Fundus photo:
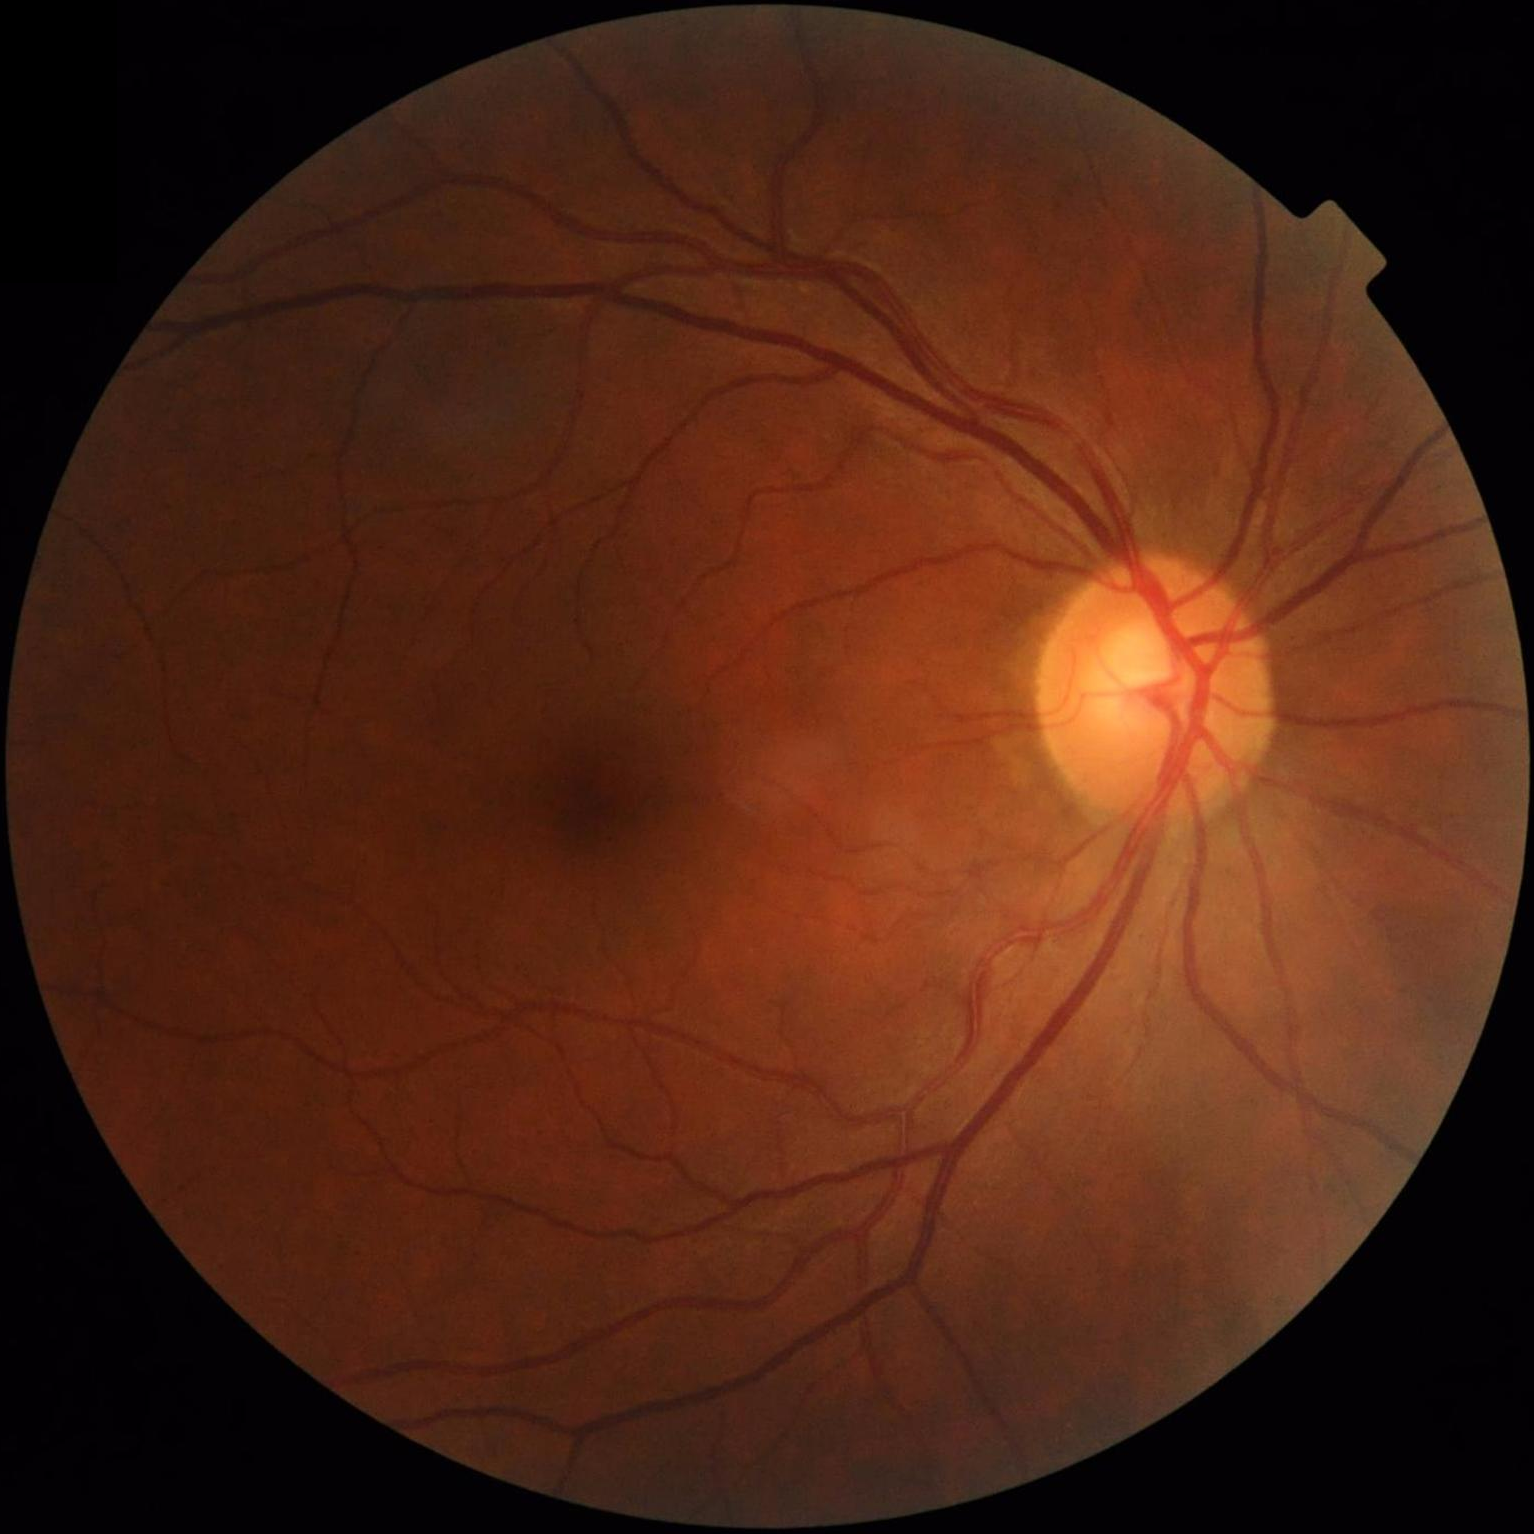   clarity: sharp throughout the field
  contrast: wide intensity range, structures distinguishable
  overall_quality: good and suitable for diagnostic use